Portable fundus photograph — 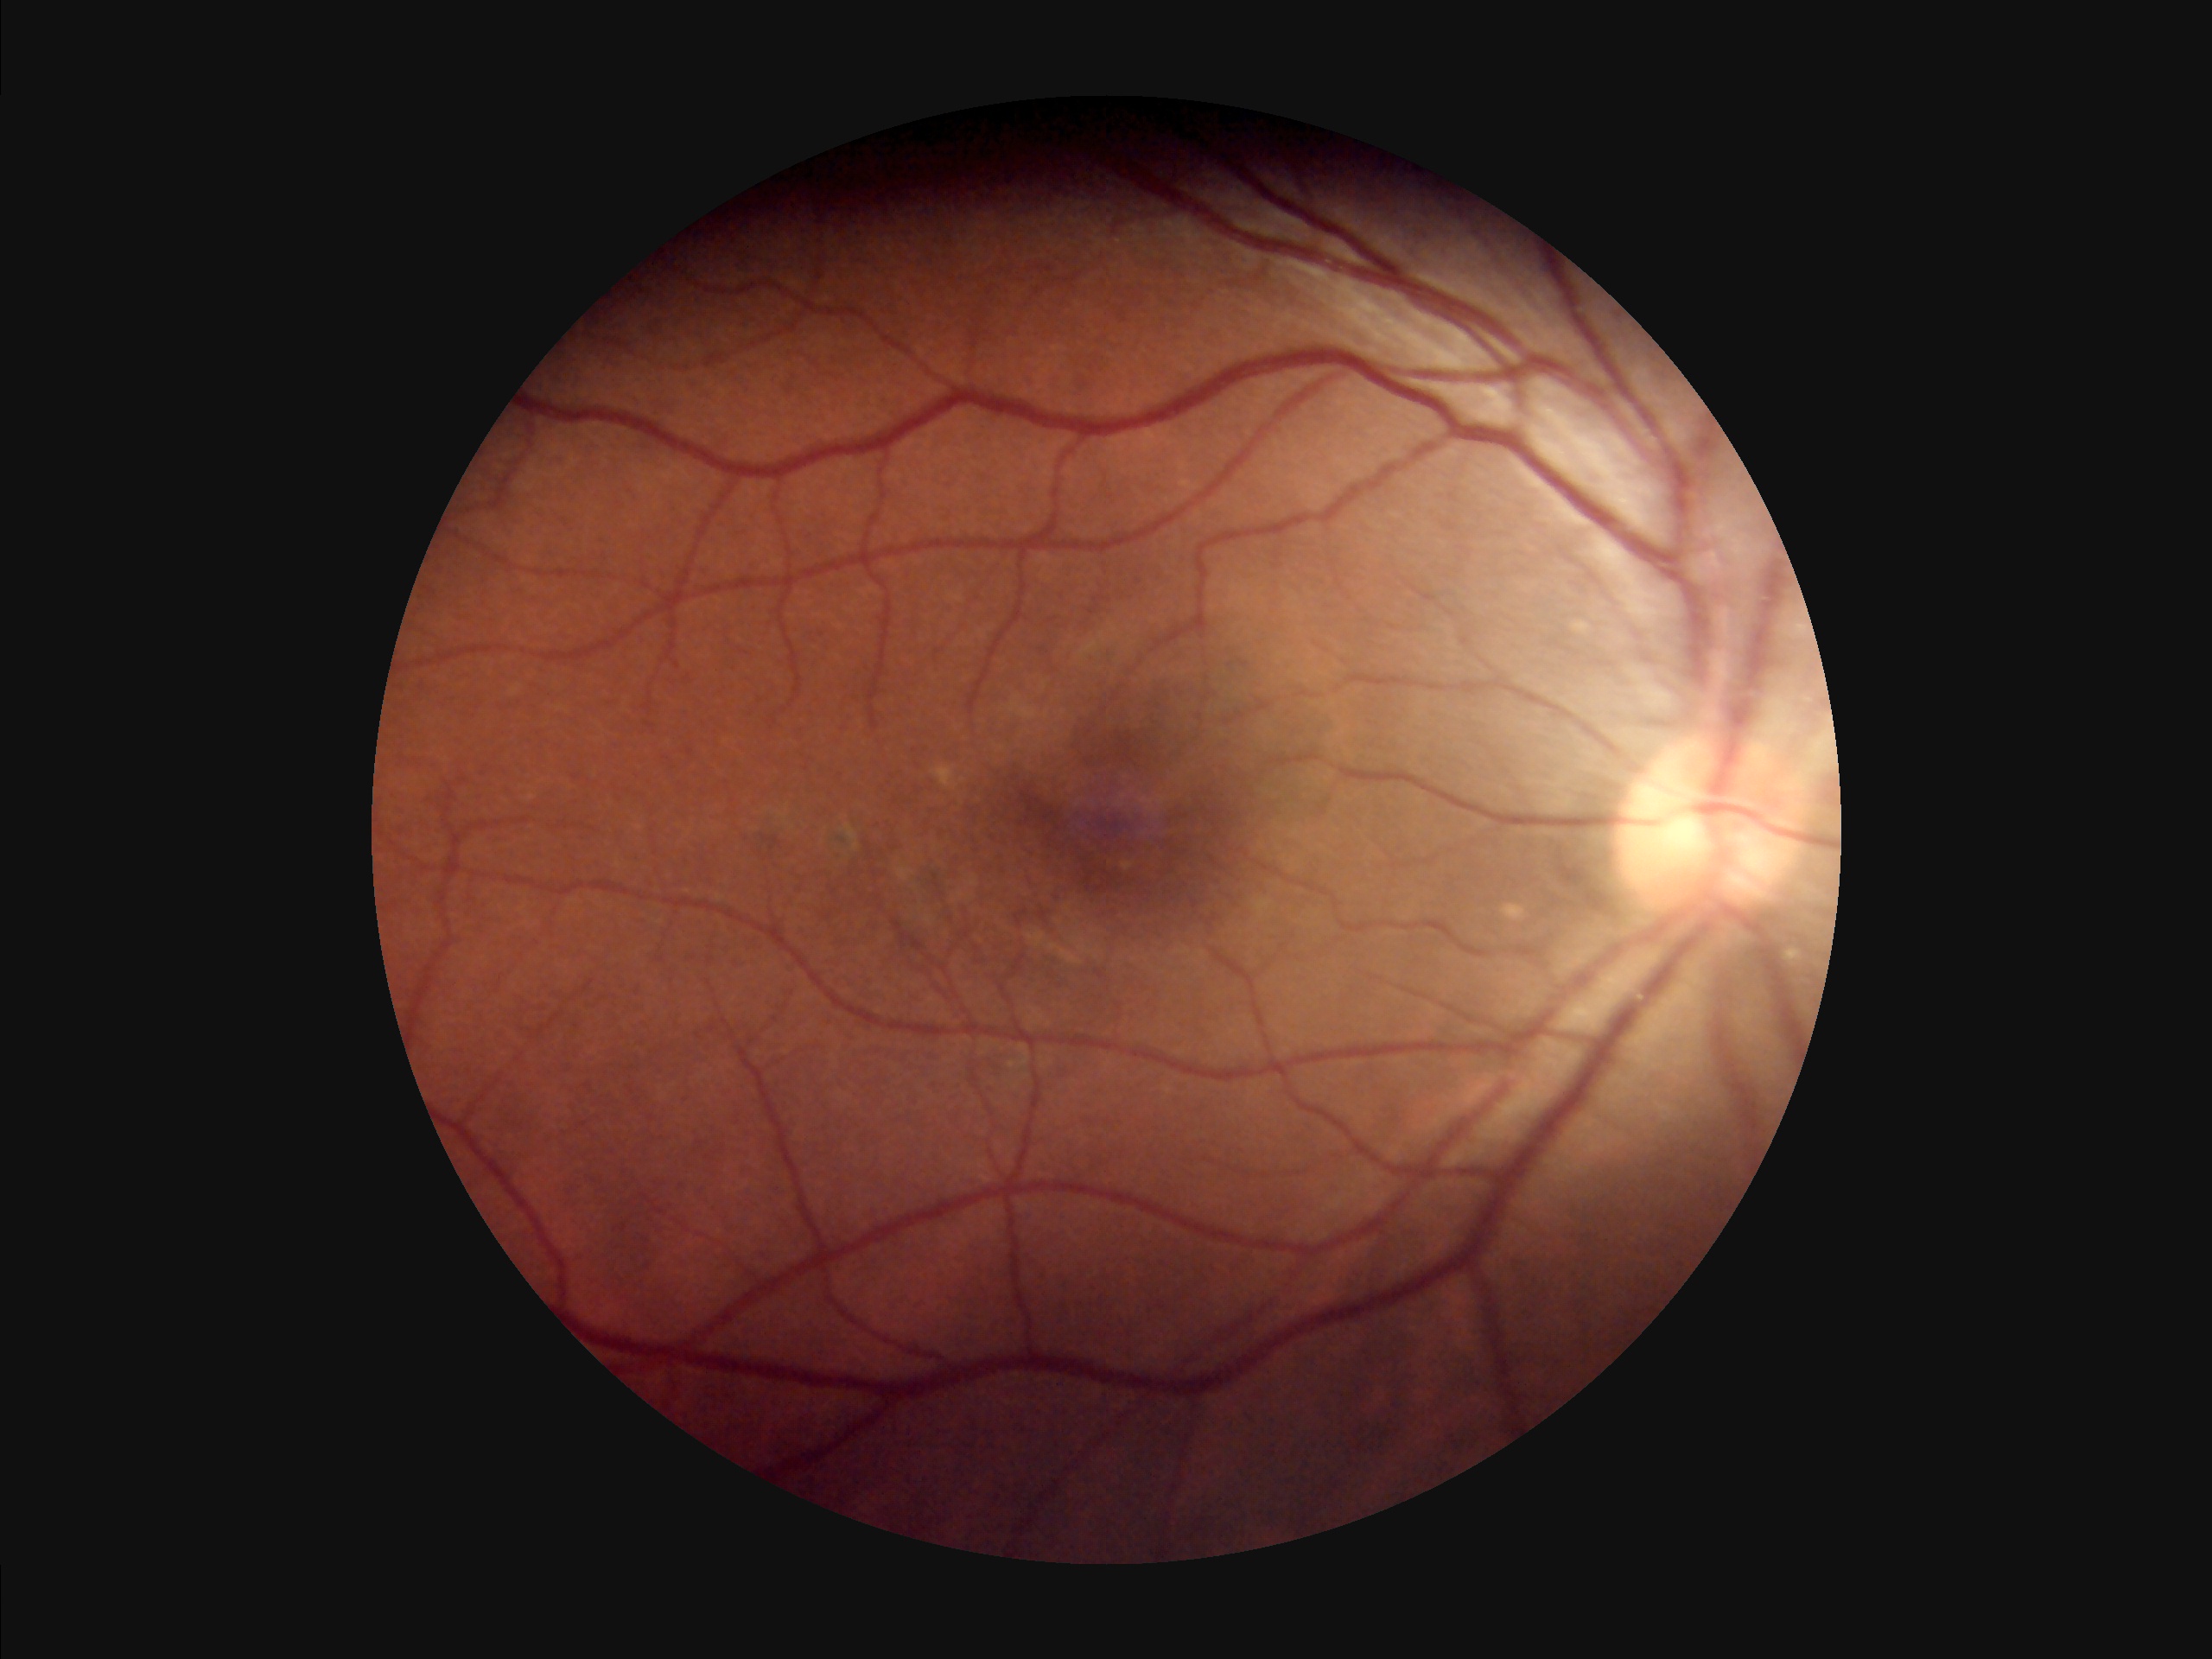
Overall = acceptable | Sharpness = clear | Contrast = adequate | Illumination/color = uneven.